1440 x 1080 pixels · wide-field fundus image from infant ROP screening · acquired on the Natus RetCam Envision: 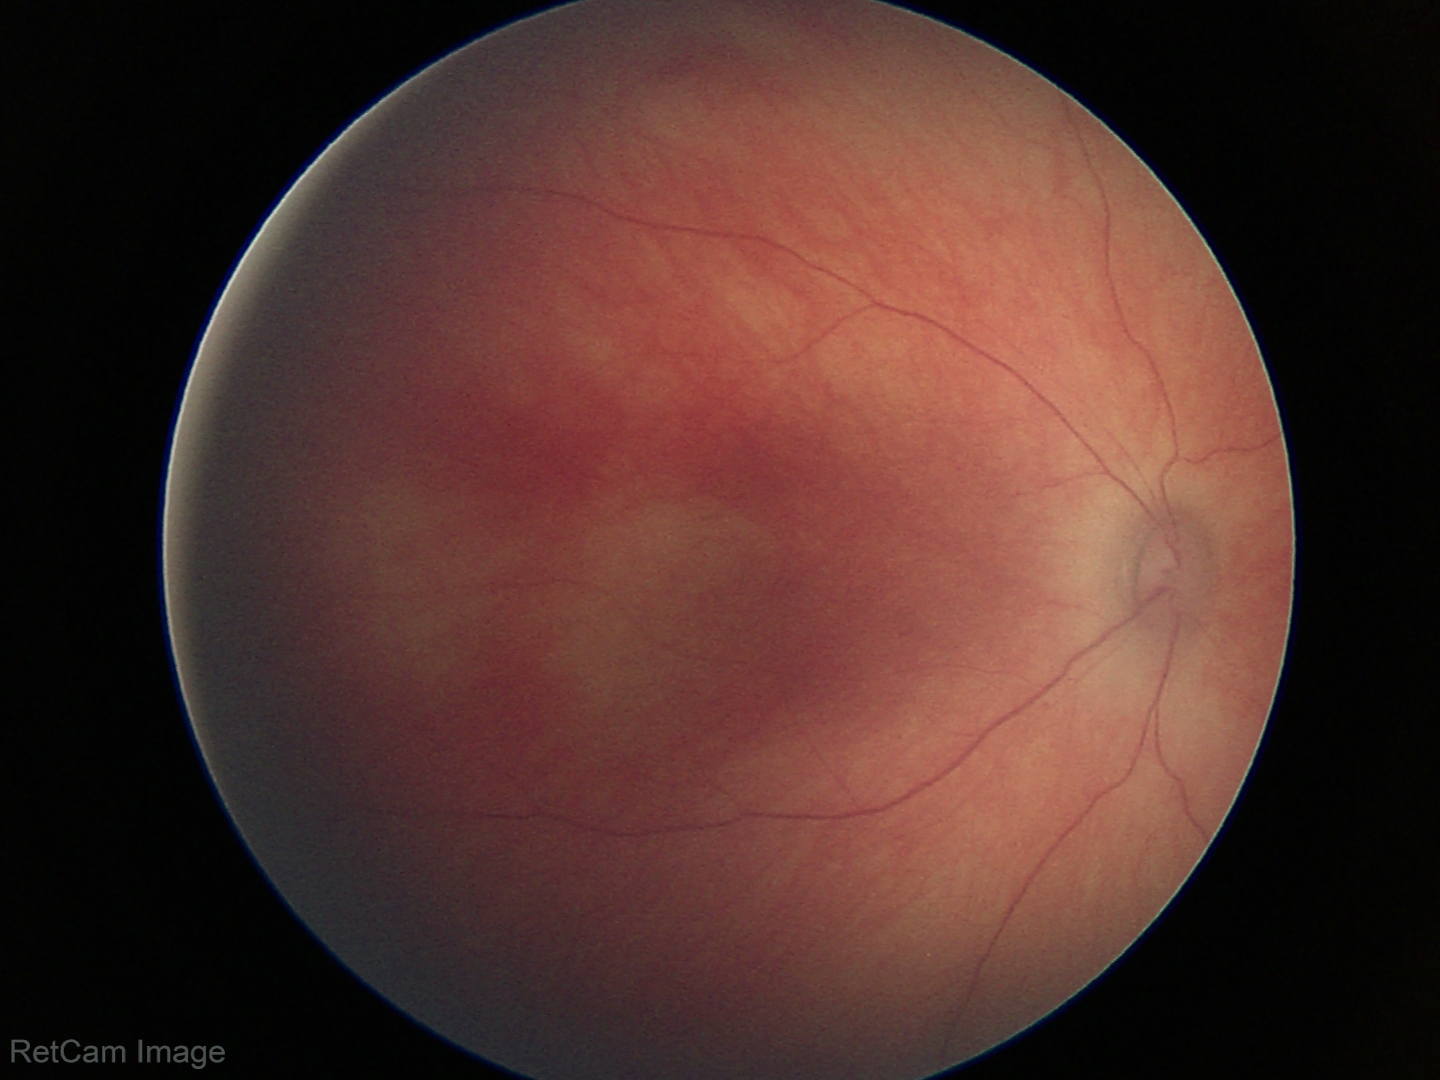

Screening diagnosis: normal retinal appearance.